Fundus photo; 45-degree field of view — 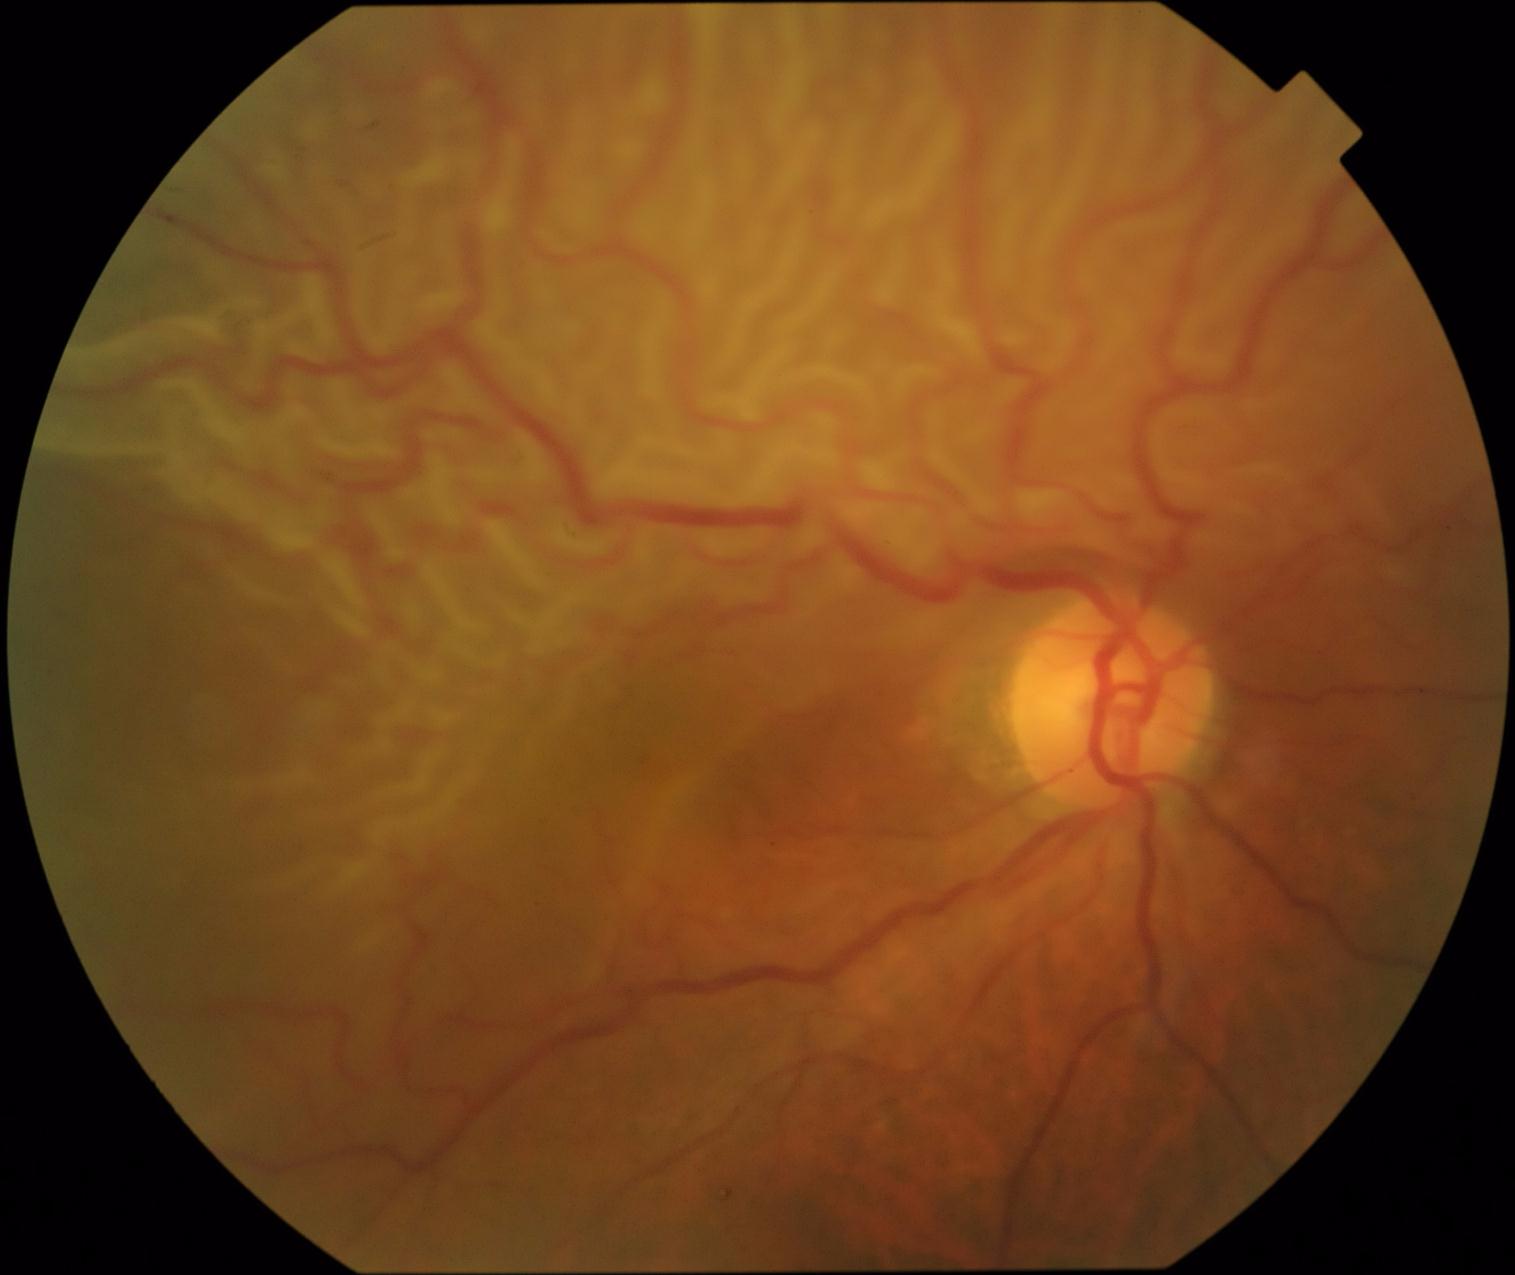

dr_grade: 4/4